1924x1556px · ultra-widefield fundus mosaic · 200° field of view
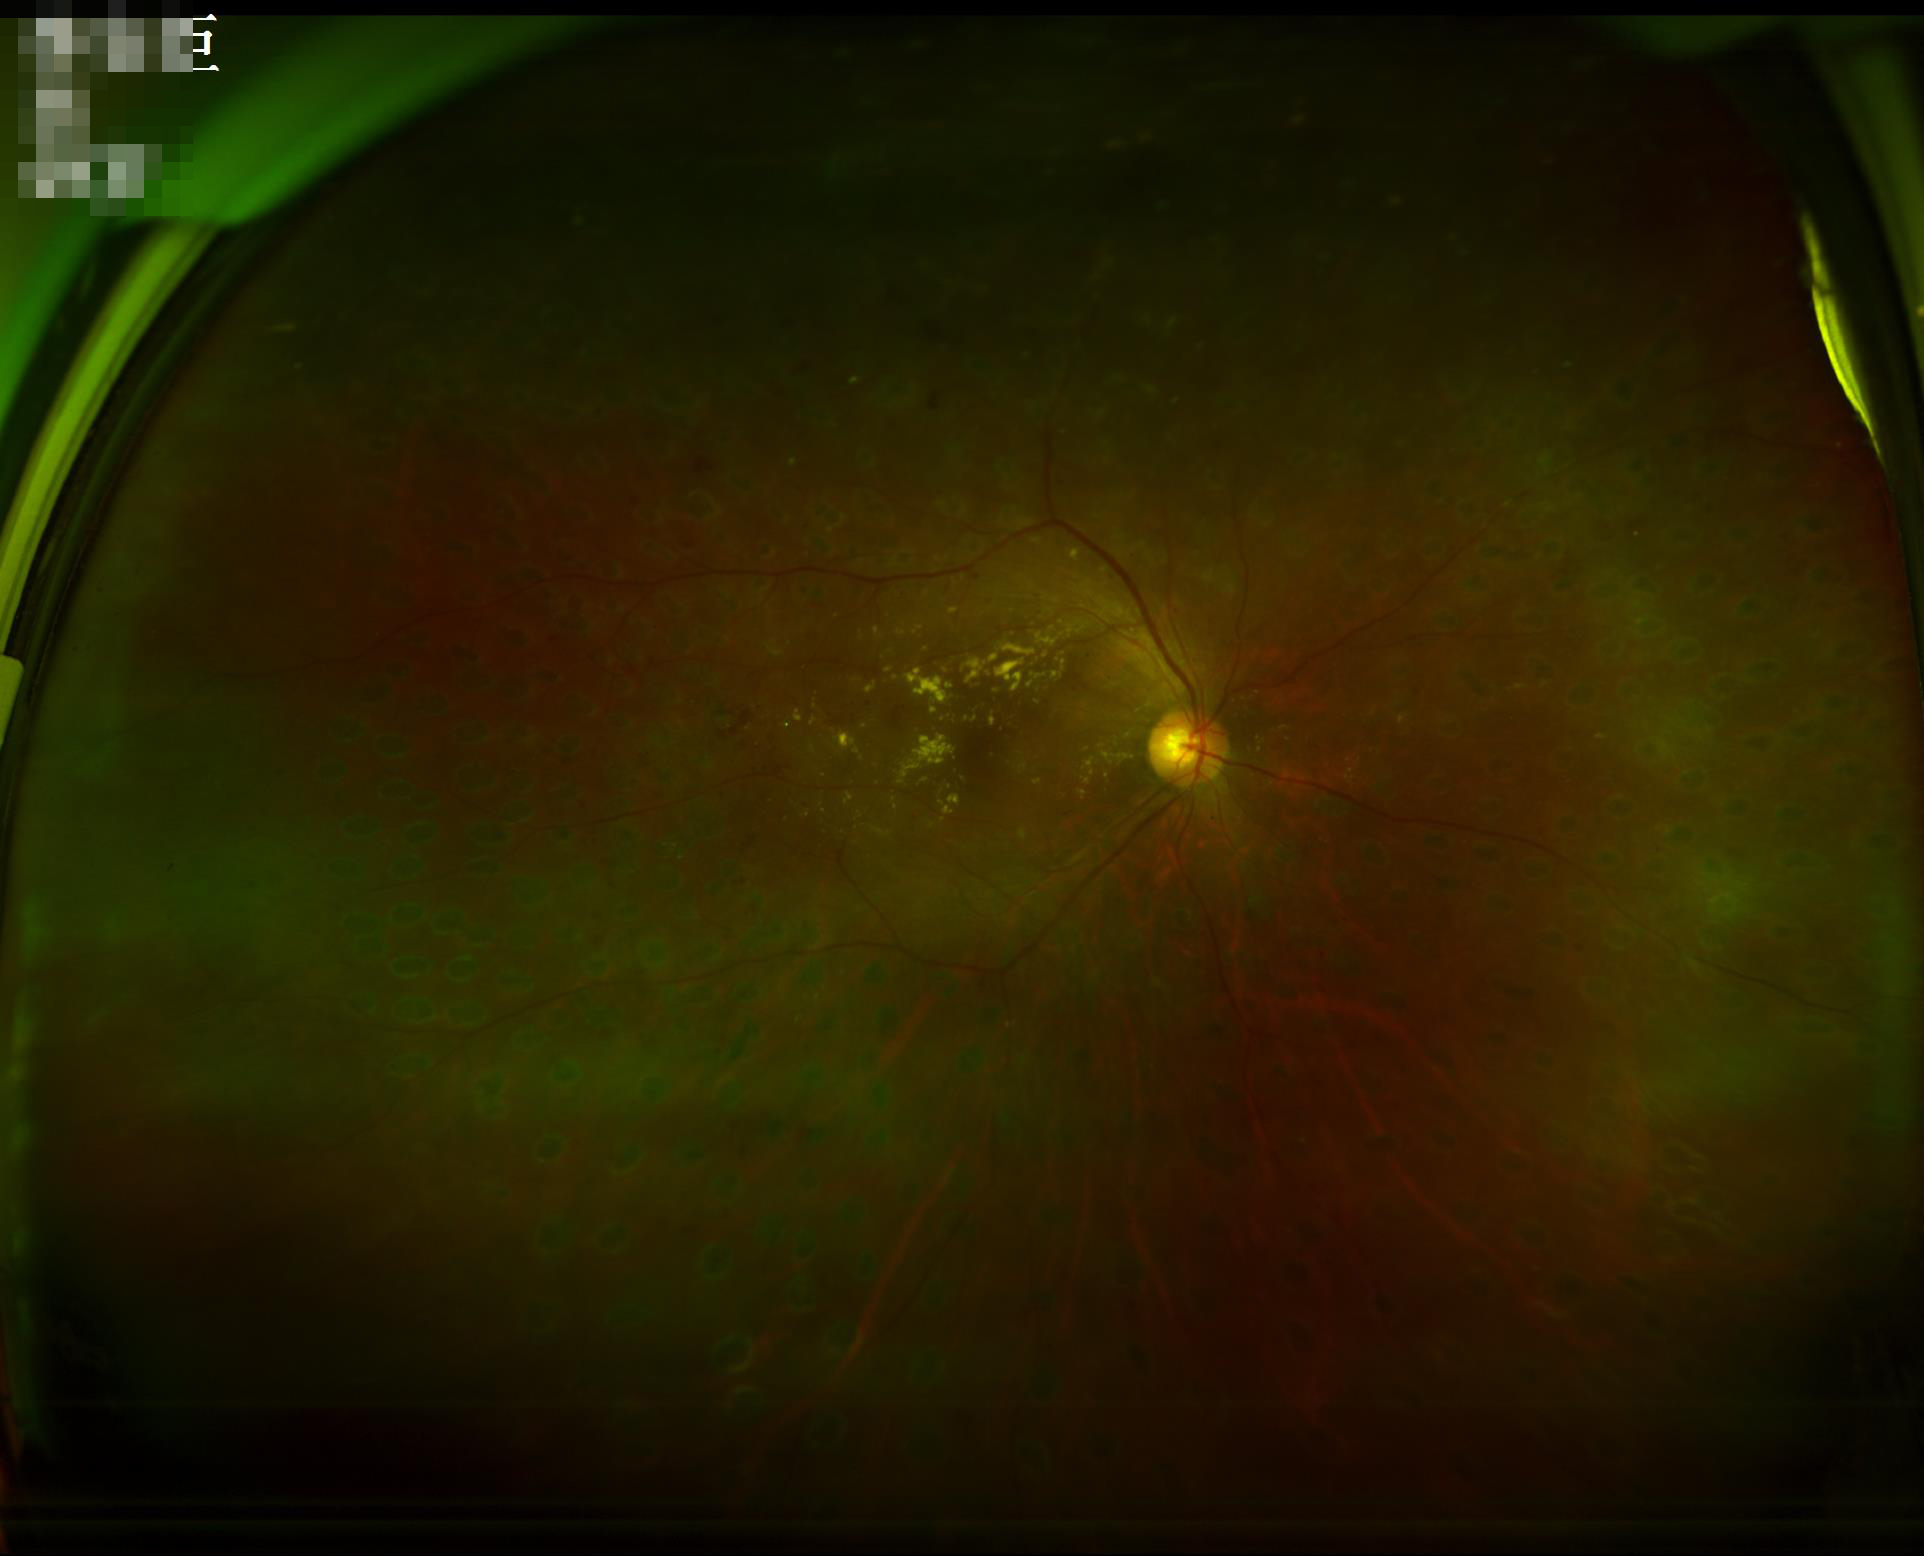

Quality assessment:
- focus: blurry
- overall: poor
- illumination/color: poor